Modified Davis classification; nonmydriatic fundus photograph — 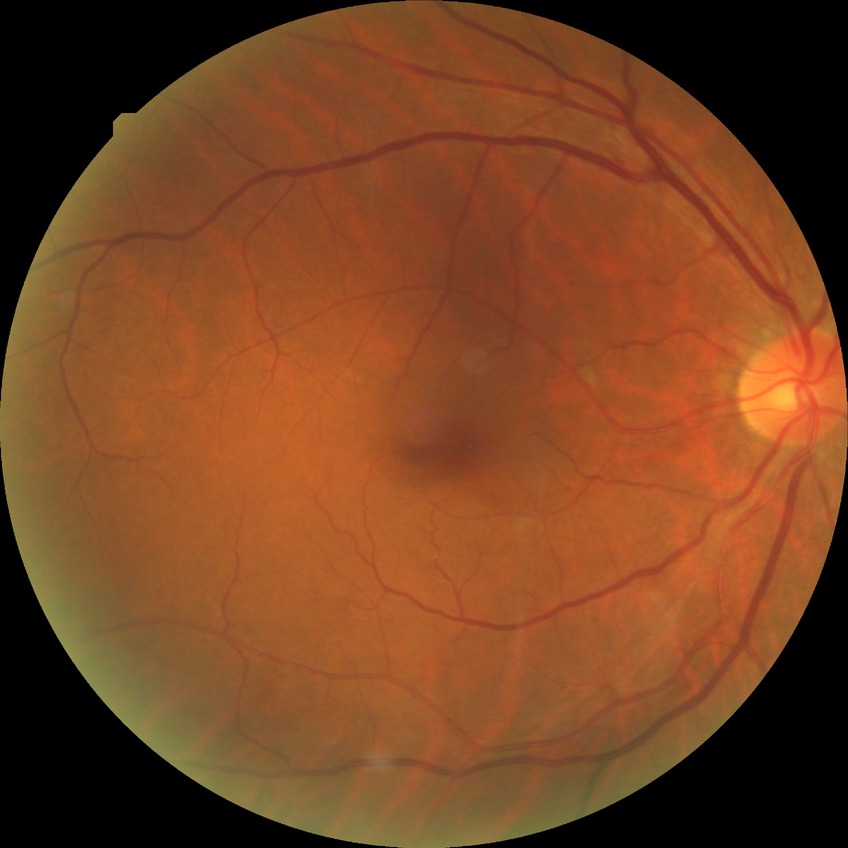

DR class: non-proliferative diabetic retinopathy. DR: SDR.